Captured with pupil dilation · fundus photograph cropped around the optic nerve head.
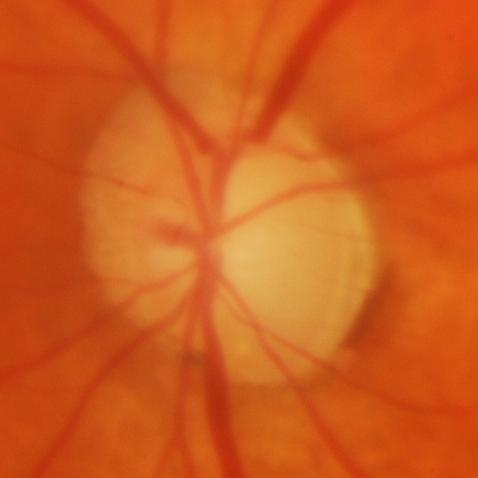 Q: Does this eye have glaucoma?
A: Glaucomatous damage to the optic nerve.